Fundus photo, 848x848px, FOV: 45 degrees — 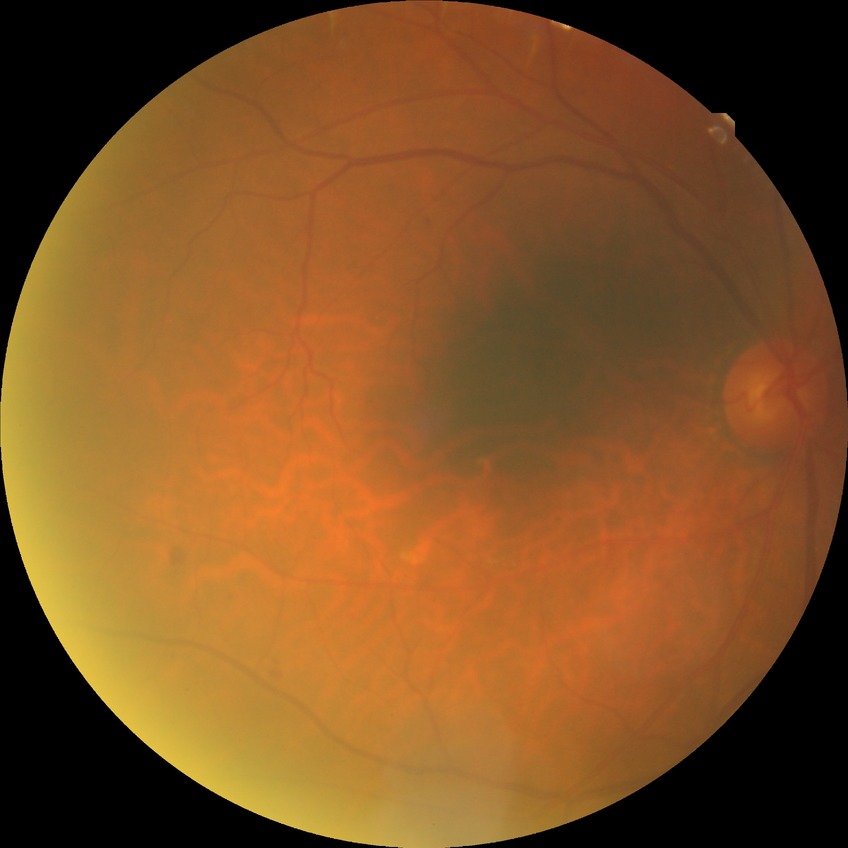 retinopathy grade: simple diabetic retinopathy.